Ultra-widefield fundus mosaic: 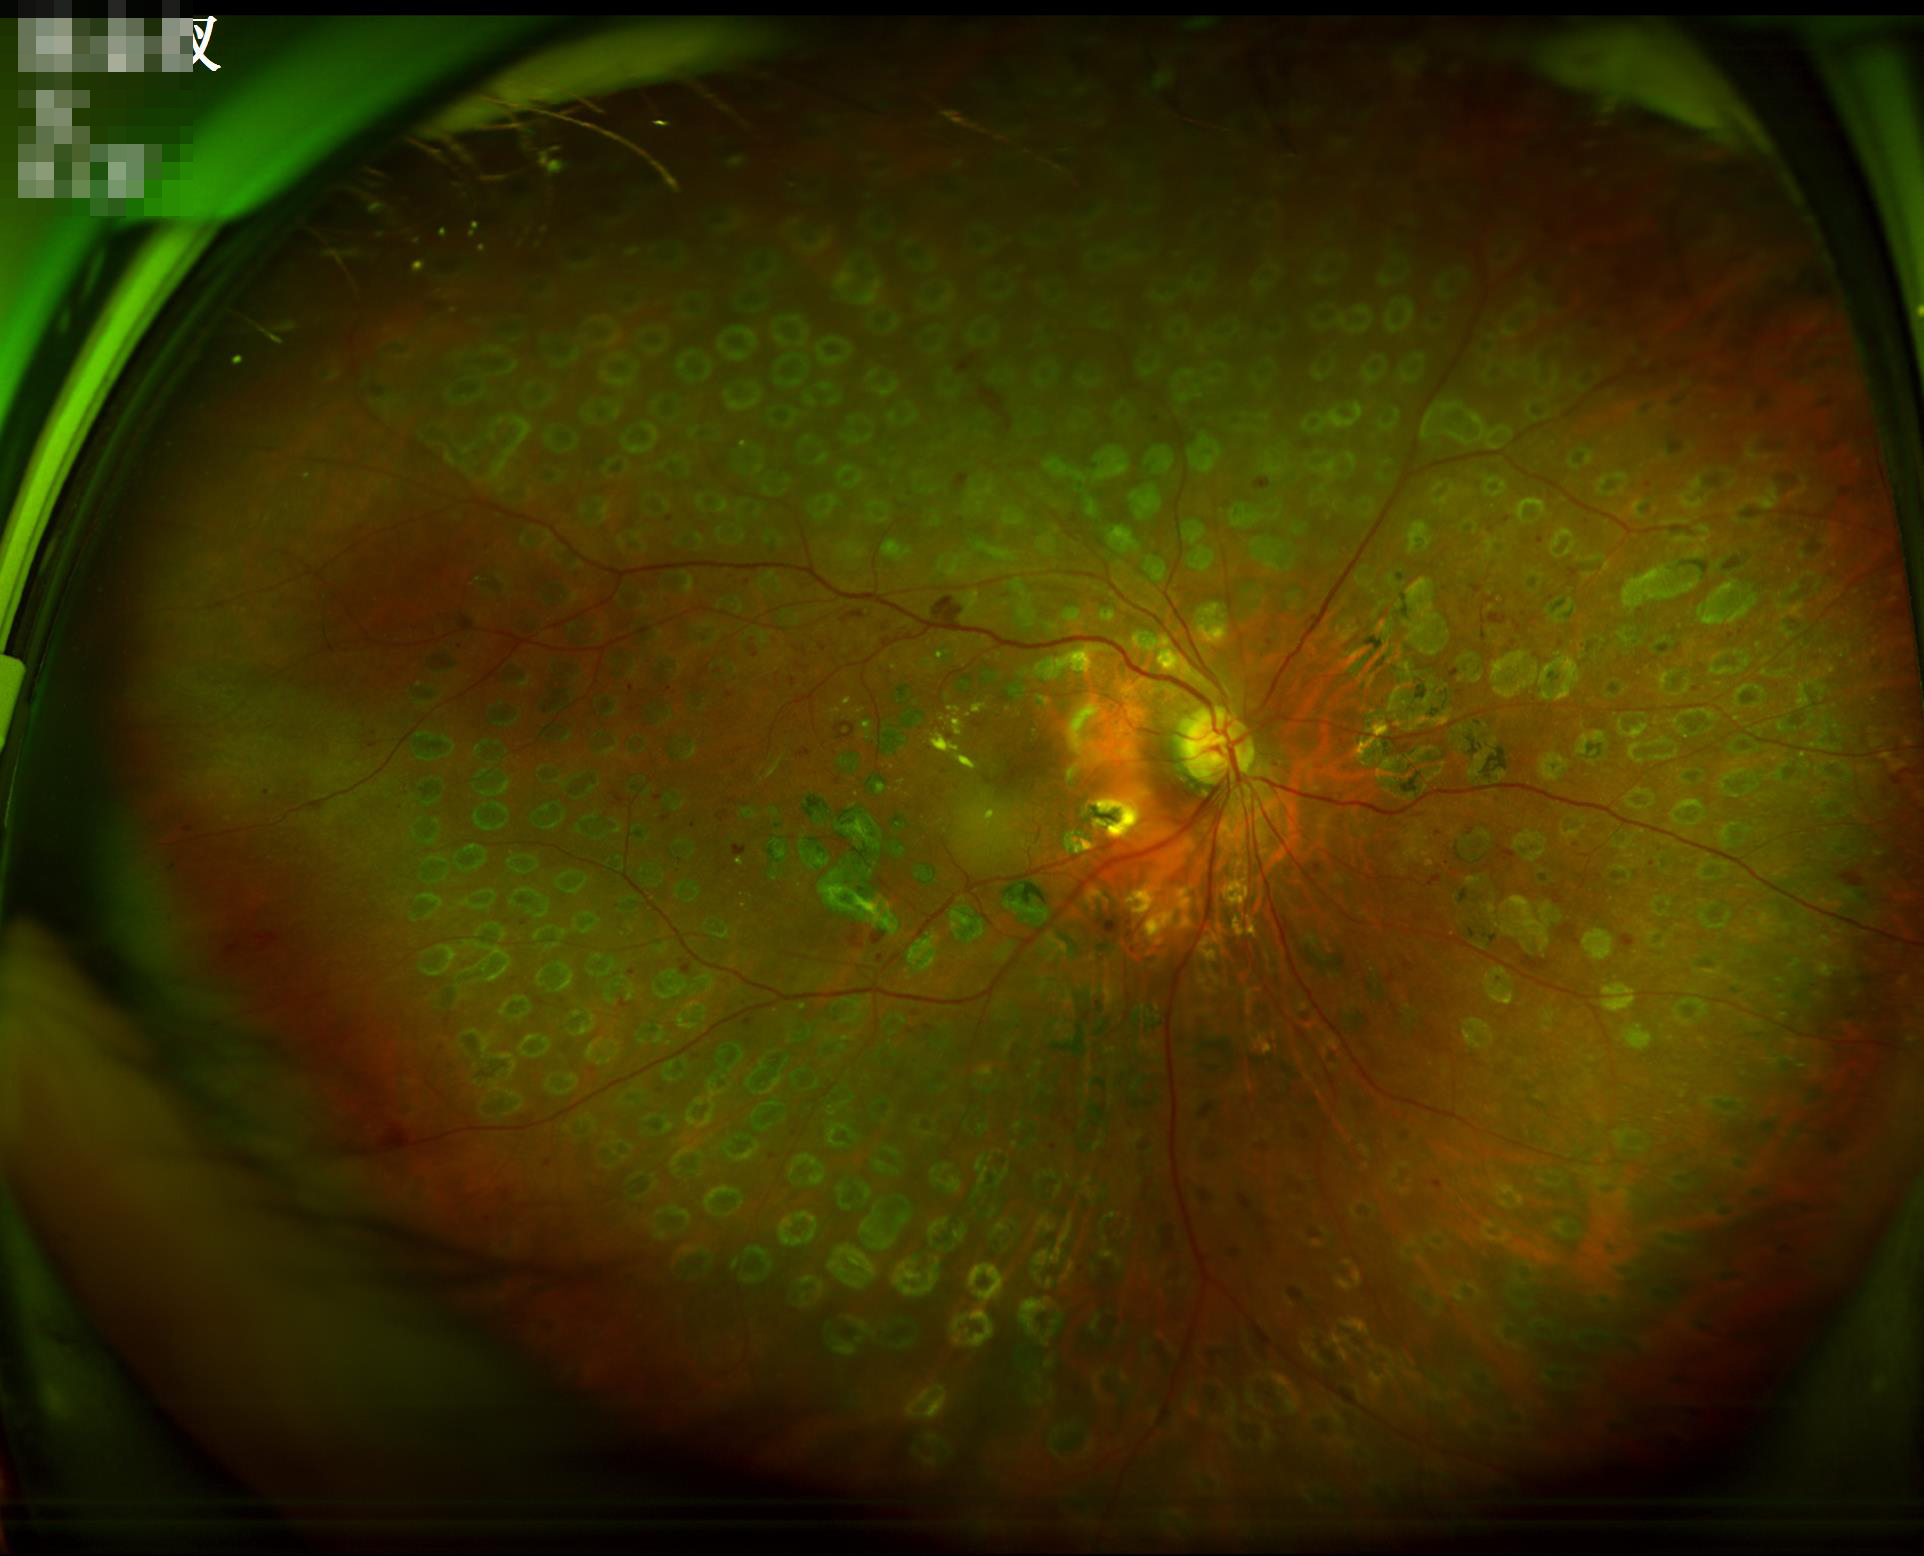
Acceptable image quality. The image is clear. Illumination is even. Vessels and details are readily distinguishable.